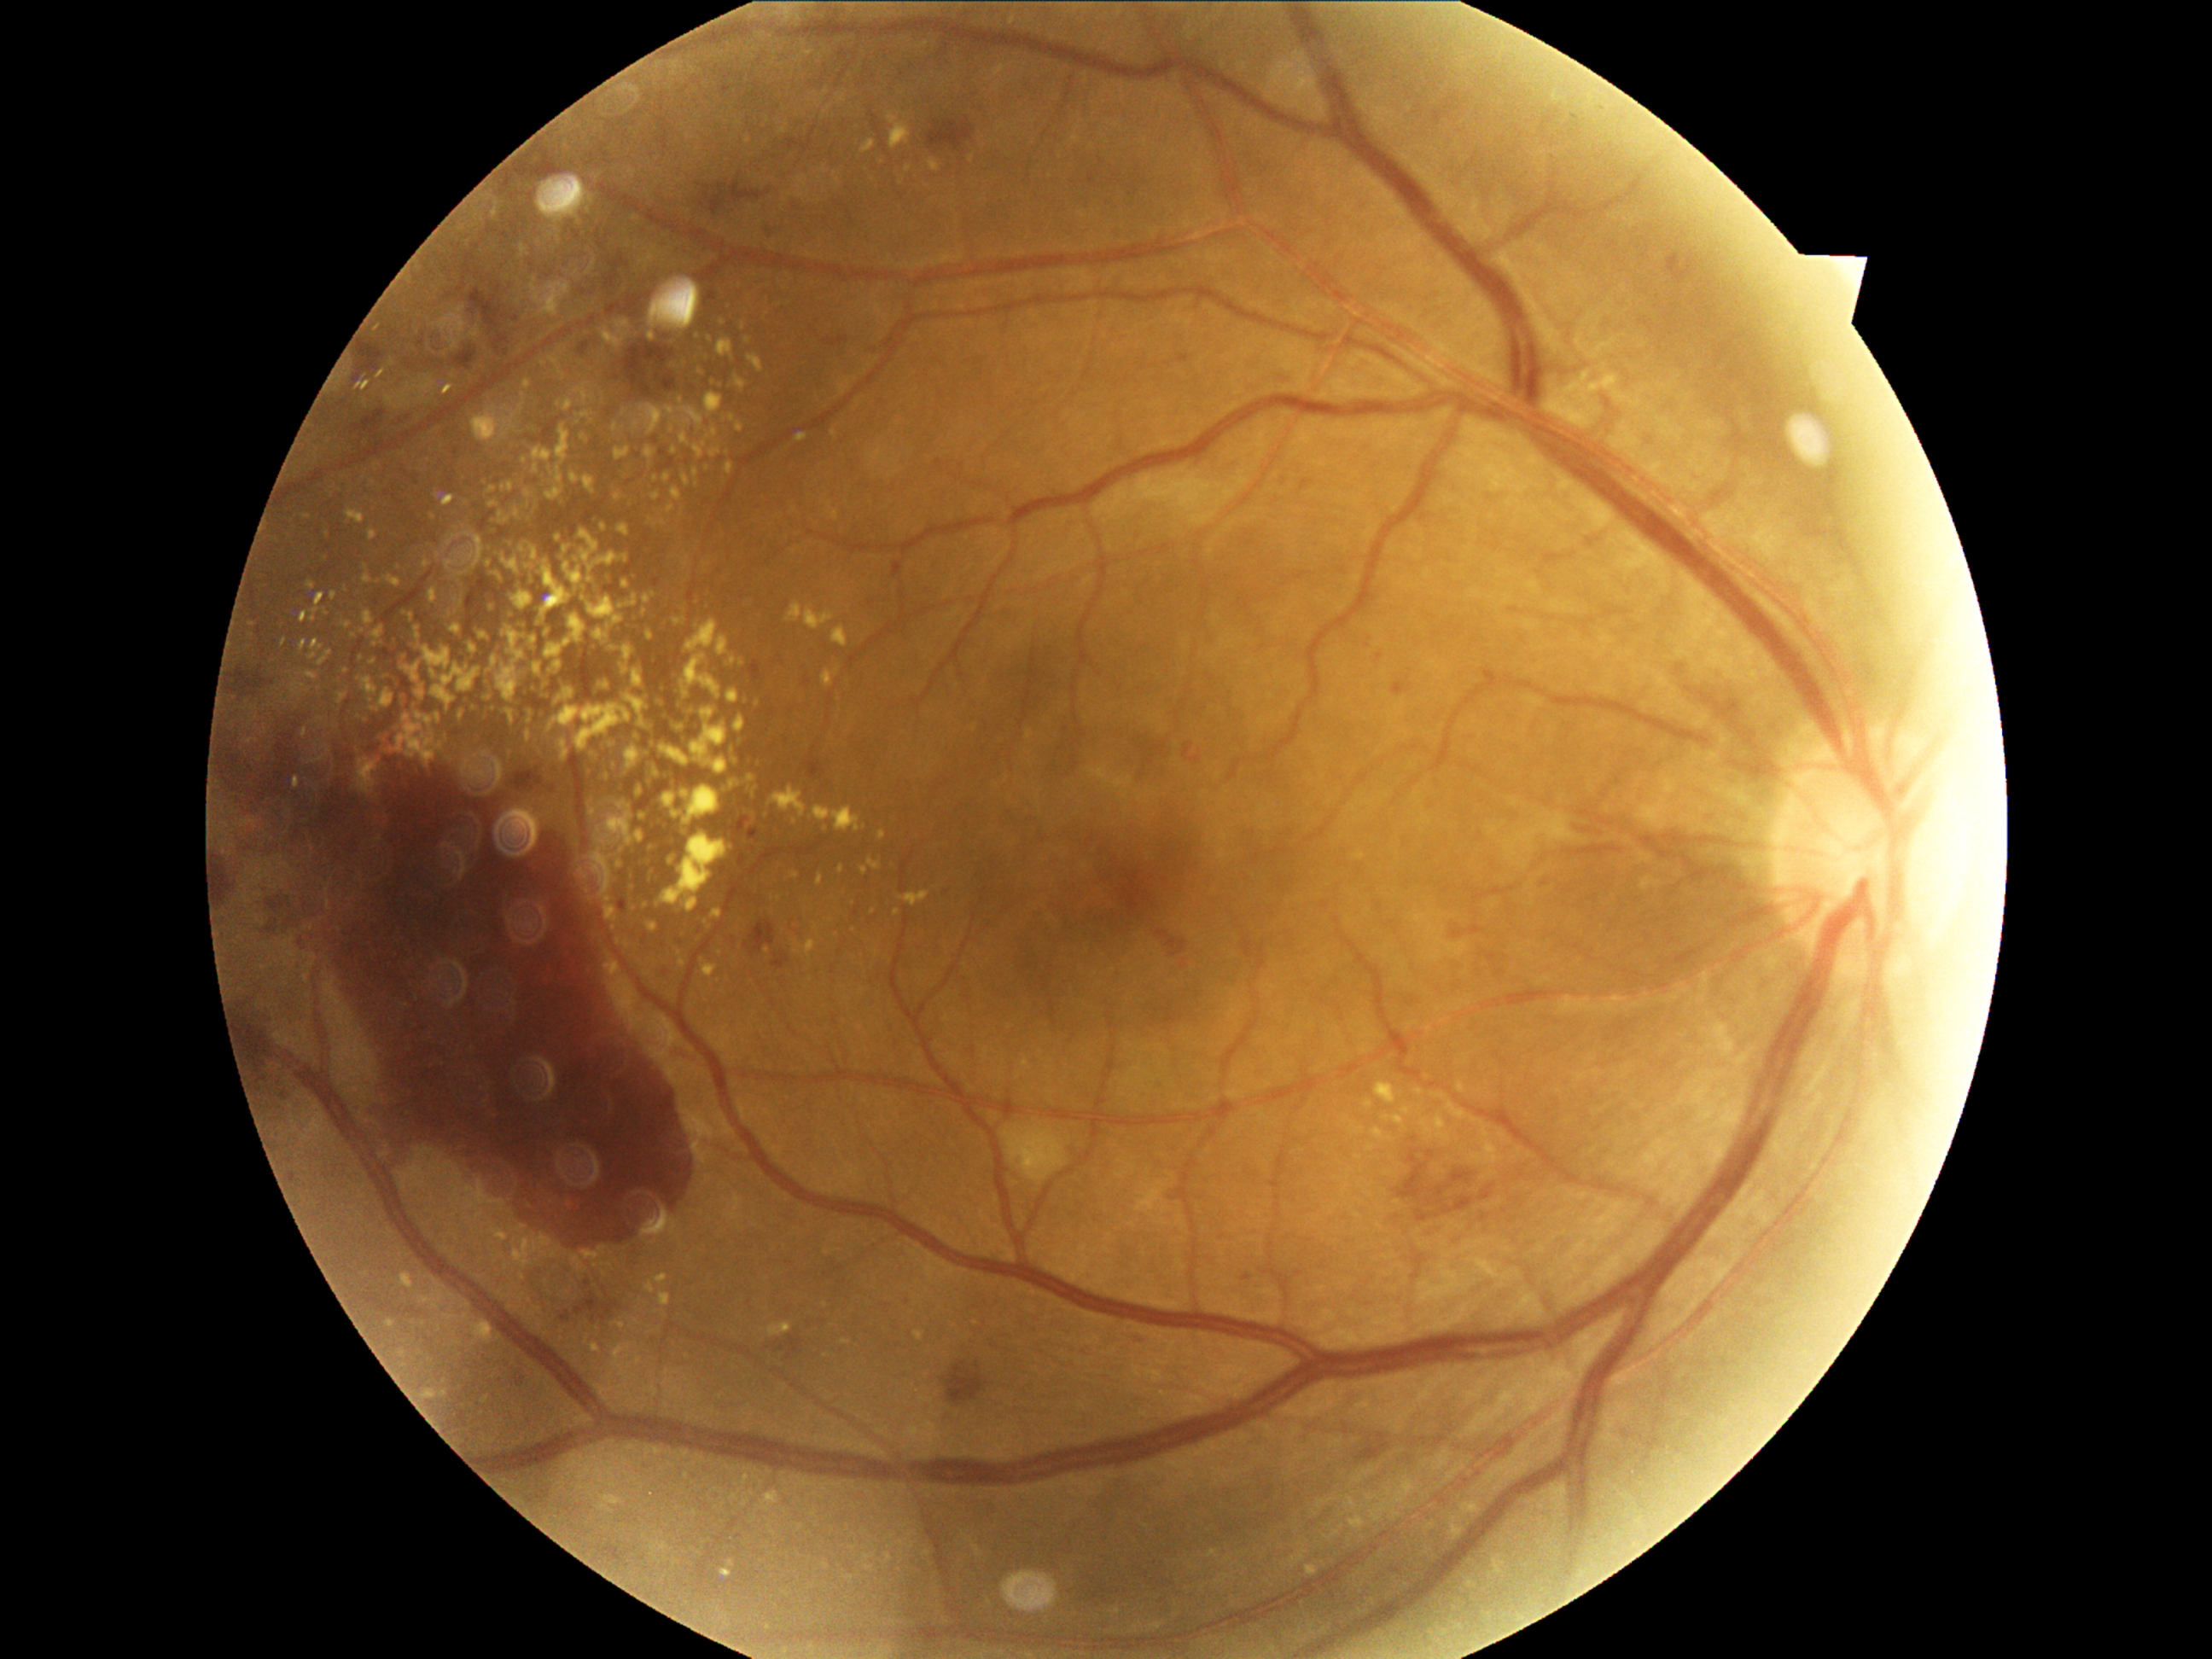
{"partial":true,"dr_grade":4,"lesions":{"ex":[[772,788,806,818],[636,832,644,842],[863,141,875,153],[614,448,631,460],[559,740,571,762],[457,581,460,590],[832,934,842,941],[463,760,487,779],[649,740,656,748],[760,943,769,952],[619,803,632,812],[735,810,740,818]],"ex_small_centers":[[661,687],[604,528],[712,342],[746,761],[333,596],[358,680],[638,1362]]}}